Nidek AFC-330. Non-mydriatic acquisition: 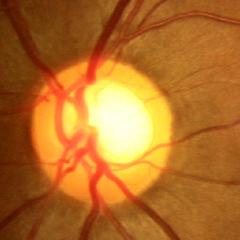
No glaucomatous changes.